Acquired on the Natus RetCam Envision · wide-field fundus photograph from neonatal ROP screening.
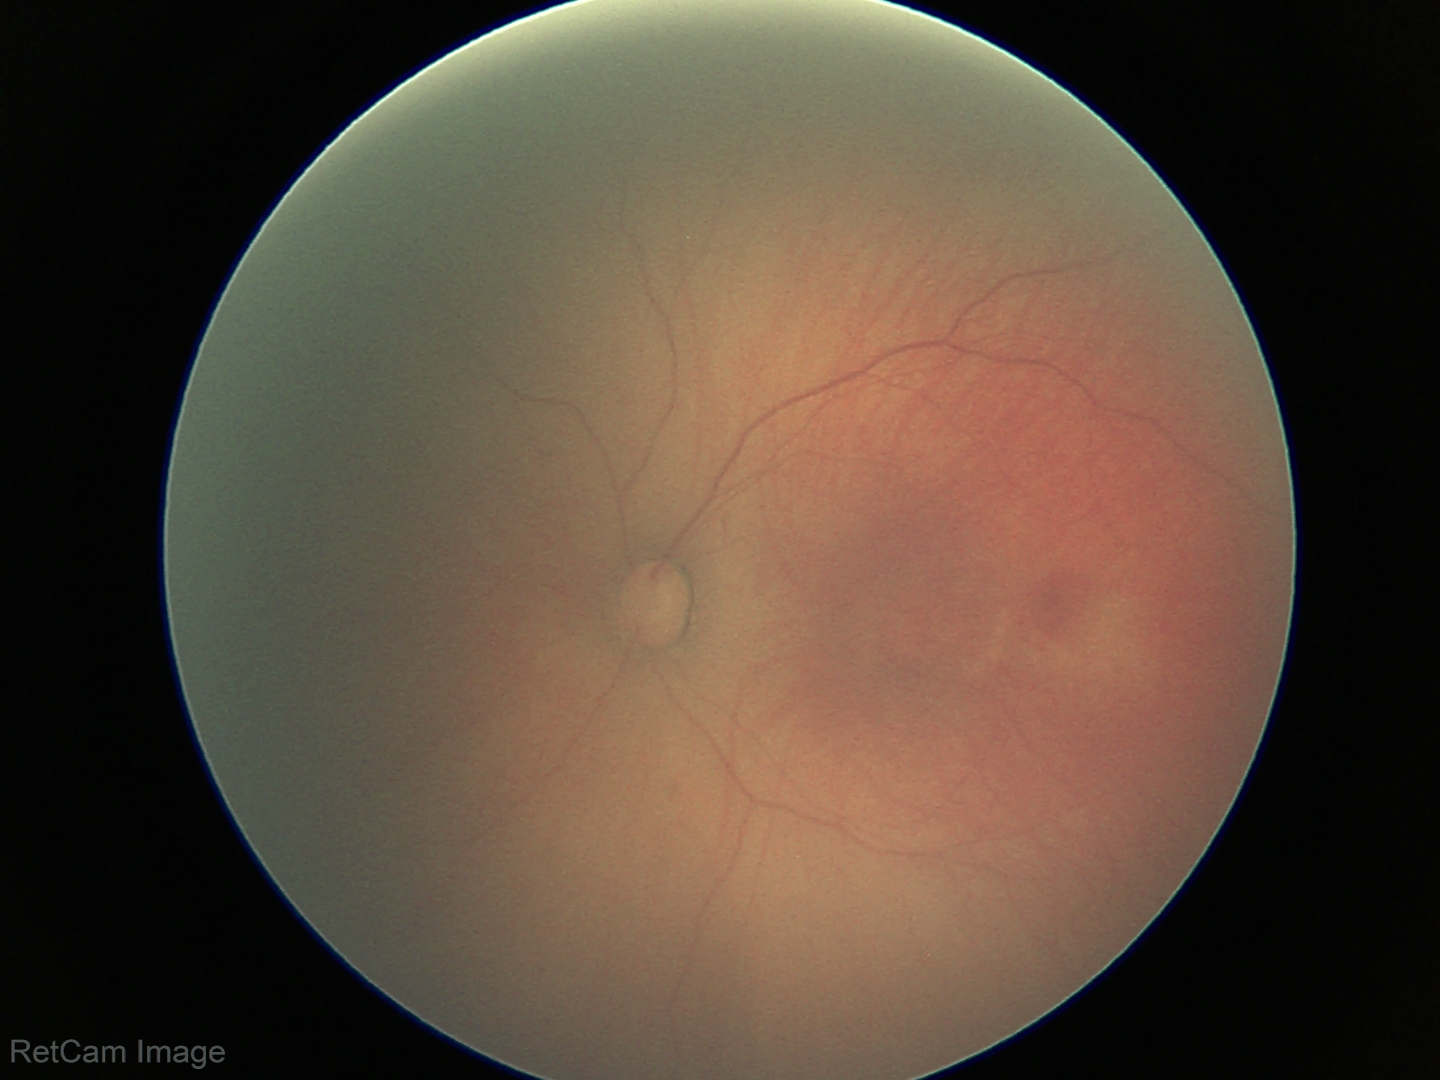

Plus disease absent.
Screening examination consistent with retinopathy of prematurity stage 1 — demarcation line between vascular and avascular retina.